1932x1932px. Fundus photo:
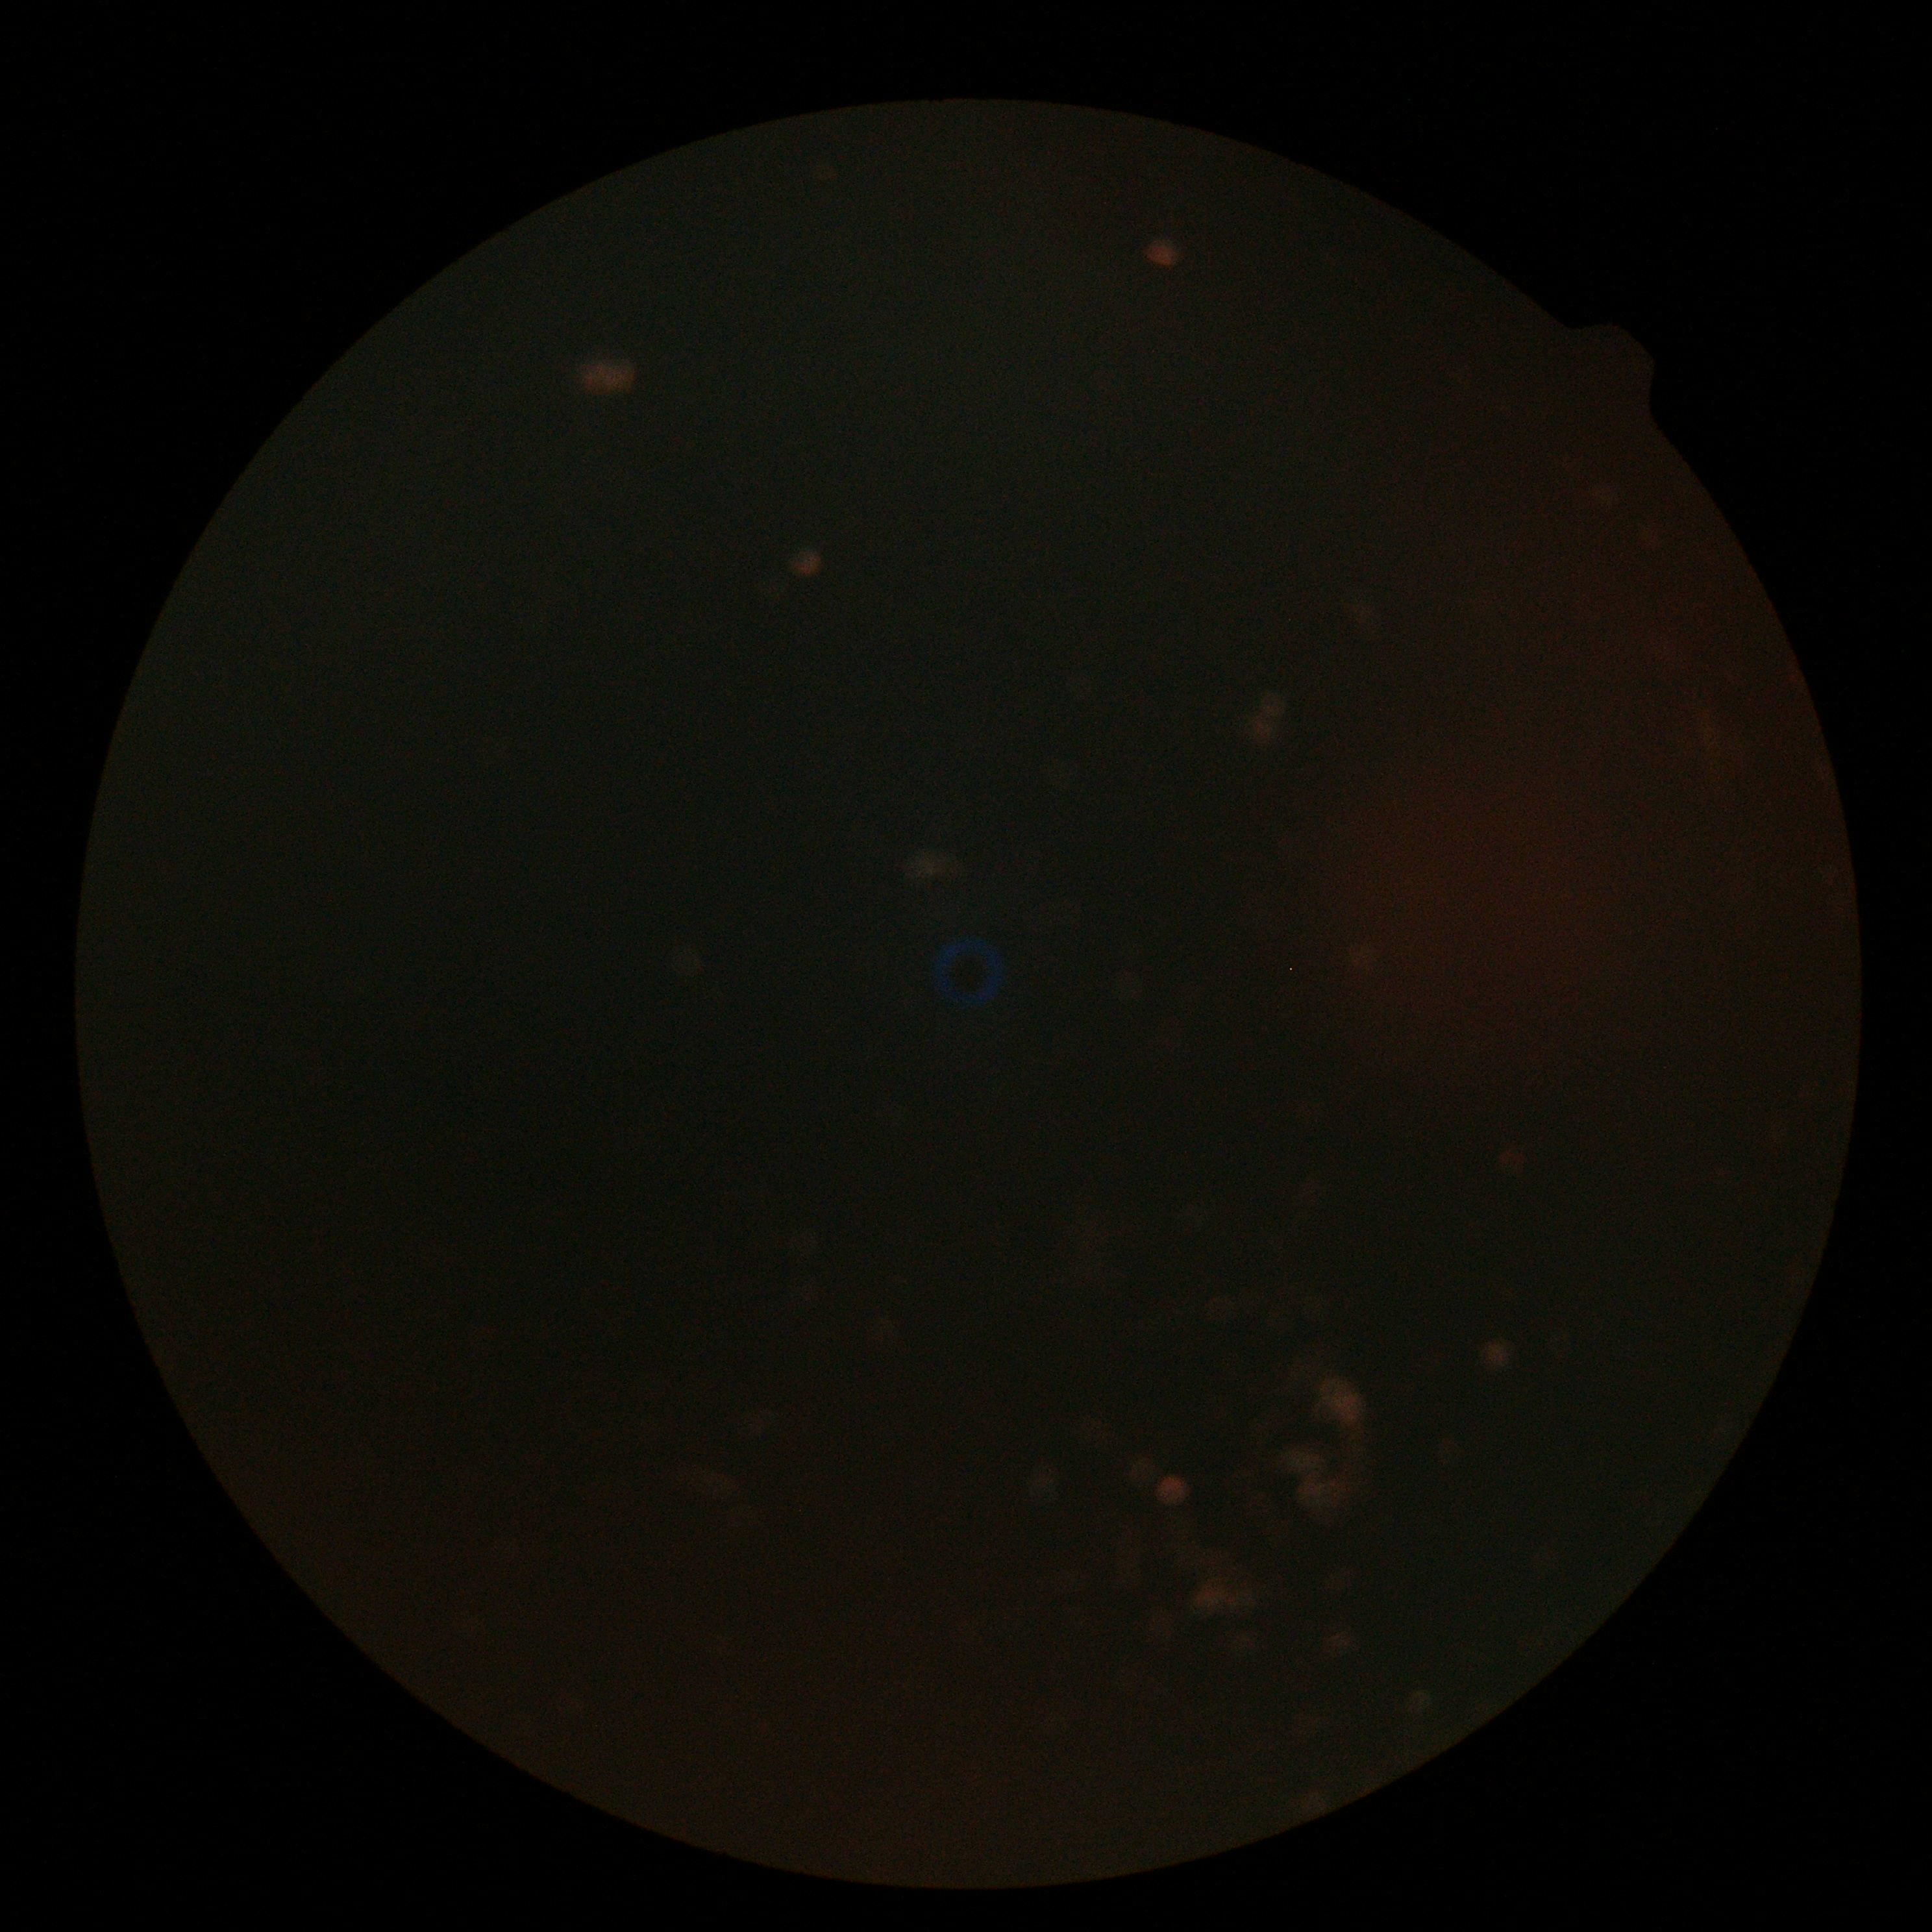
image quality=insufficient for DR assessment; diabetic retinopathy (DR)=ungradable due to poor image quality.